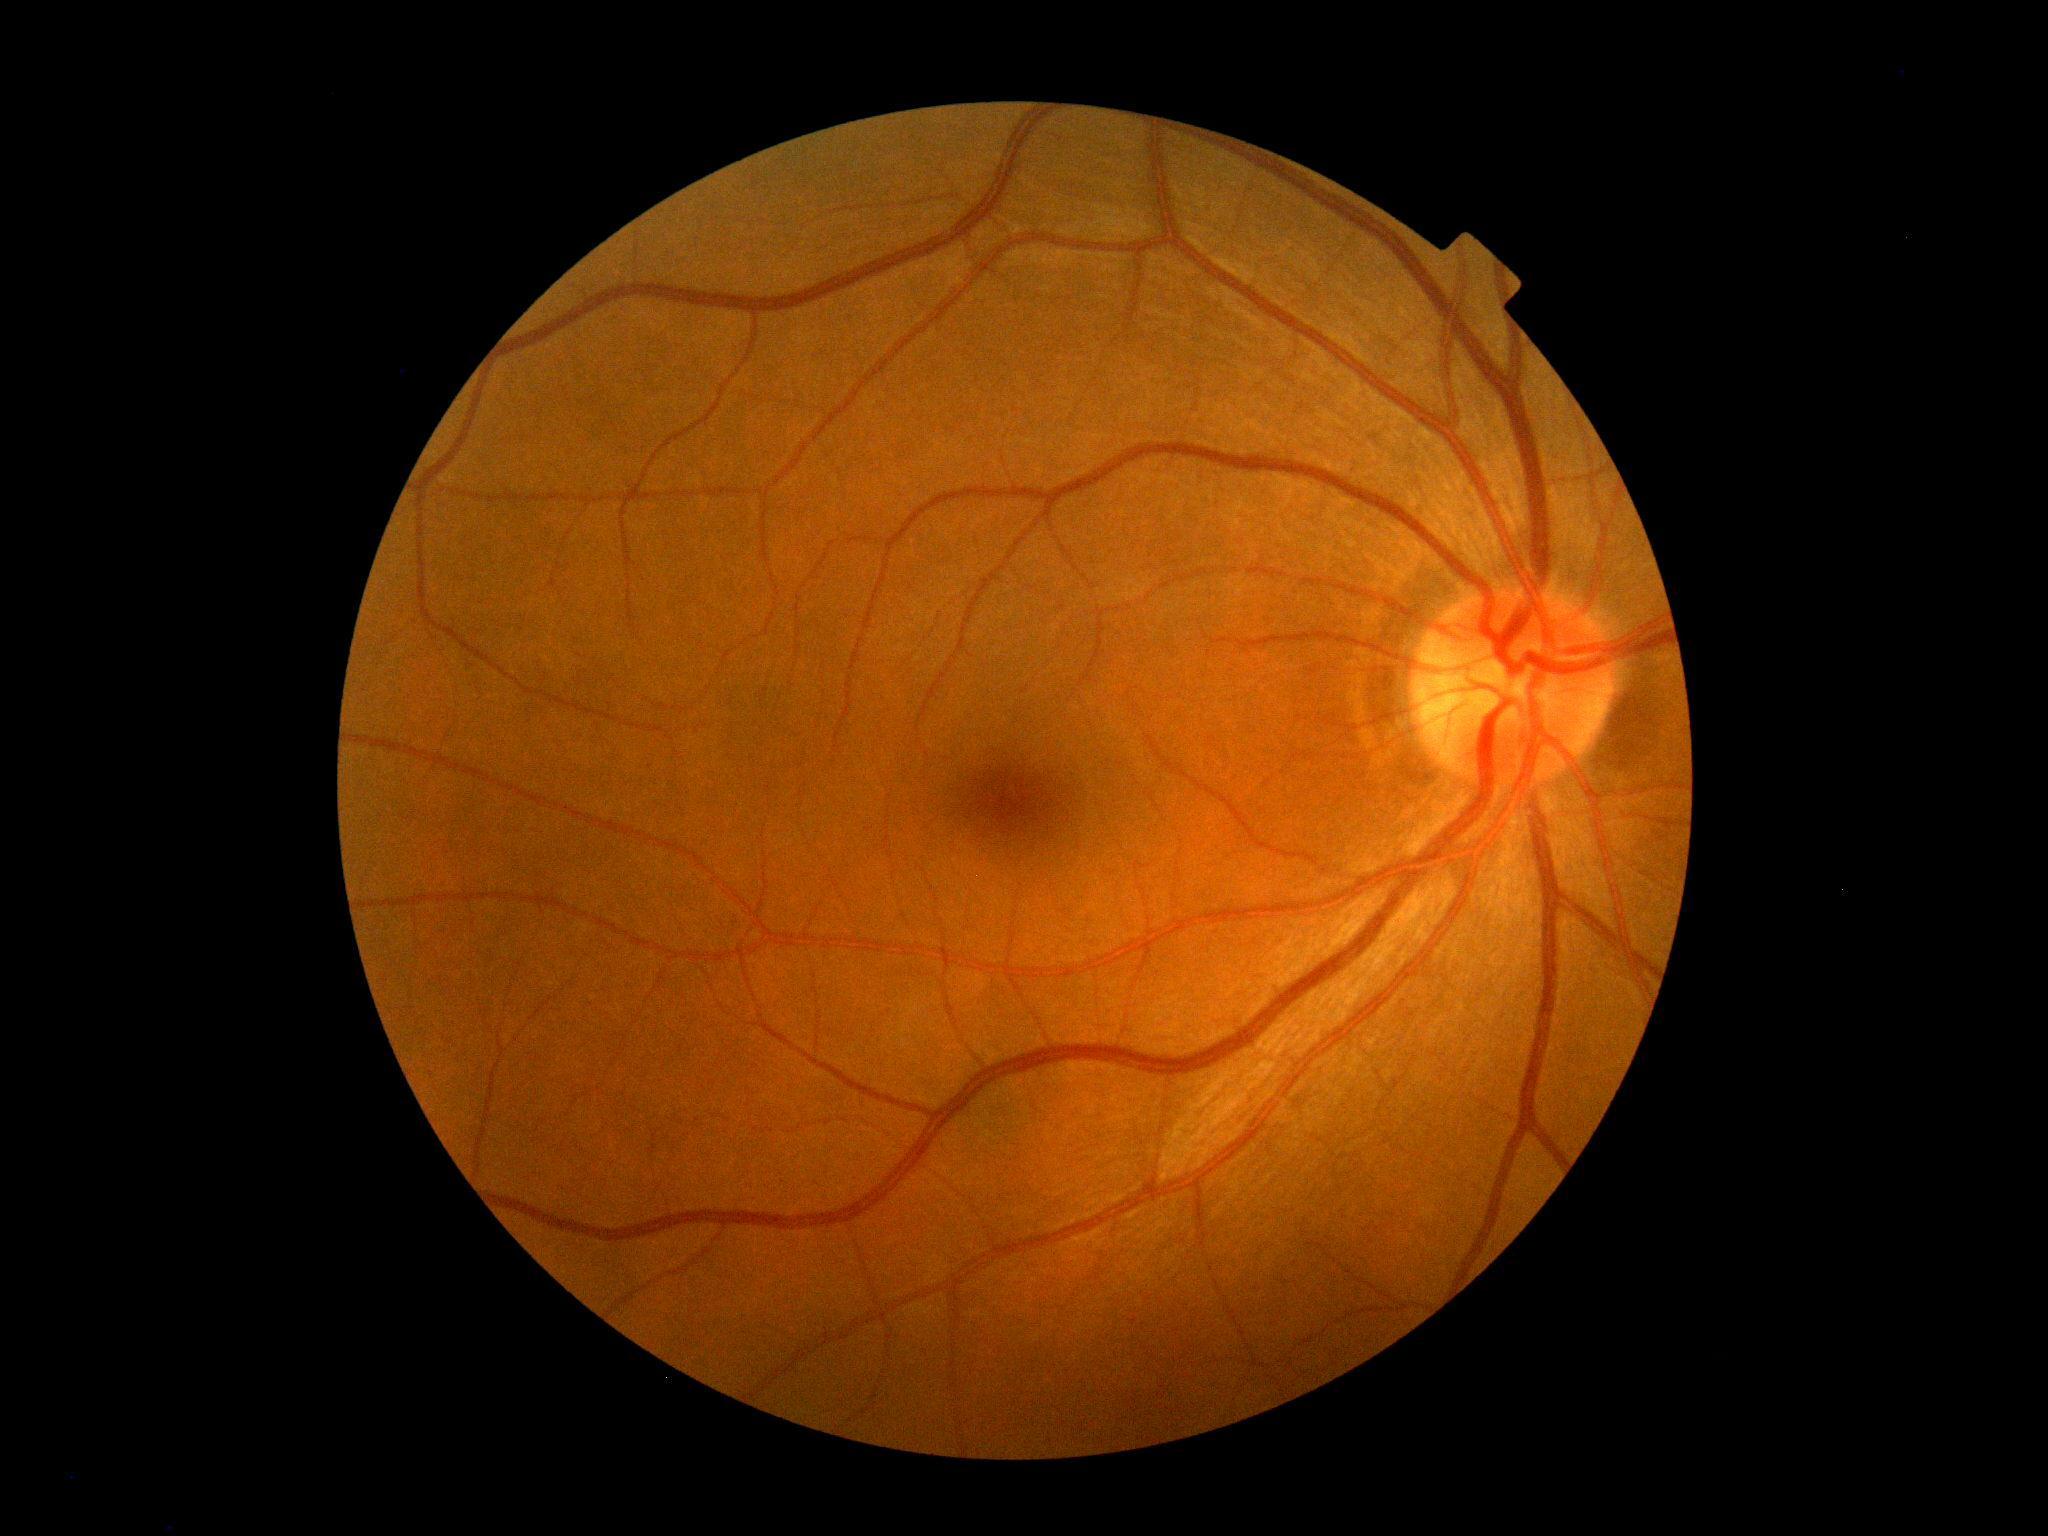 DR is grade 0 (no apparent retinopathy). No apparent diabetic retinopathy.